2352x1568px:
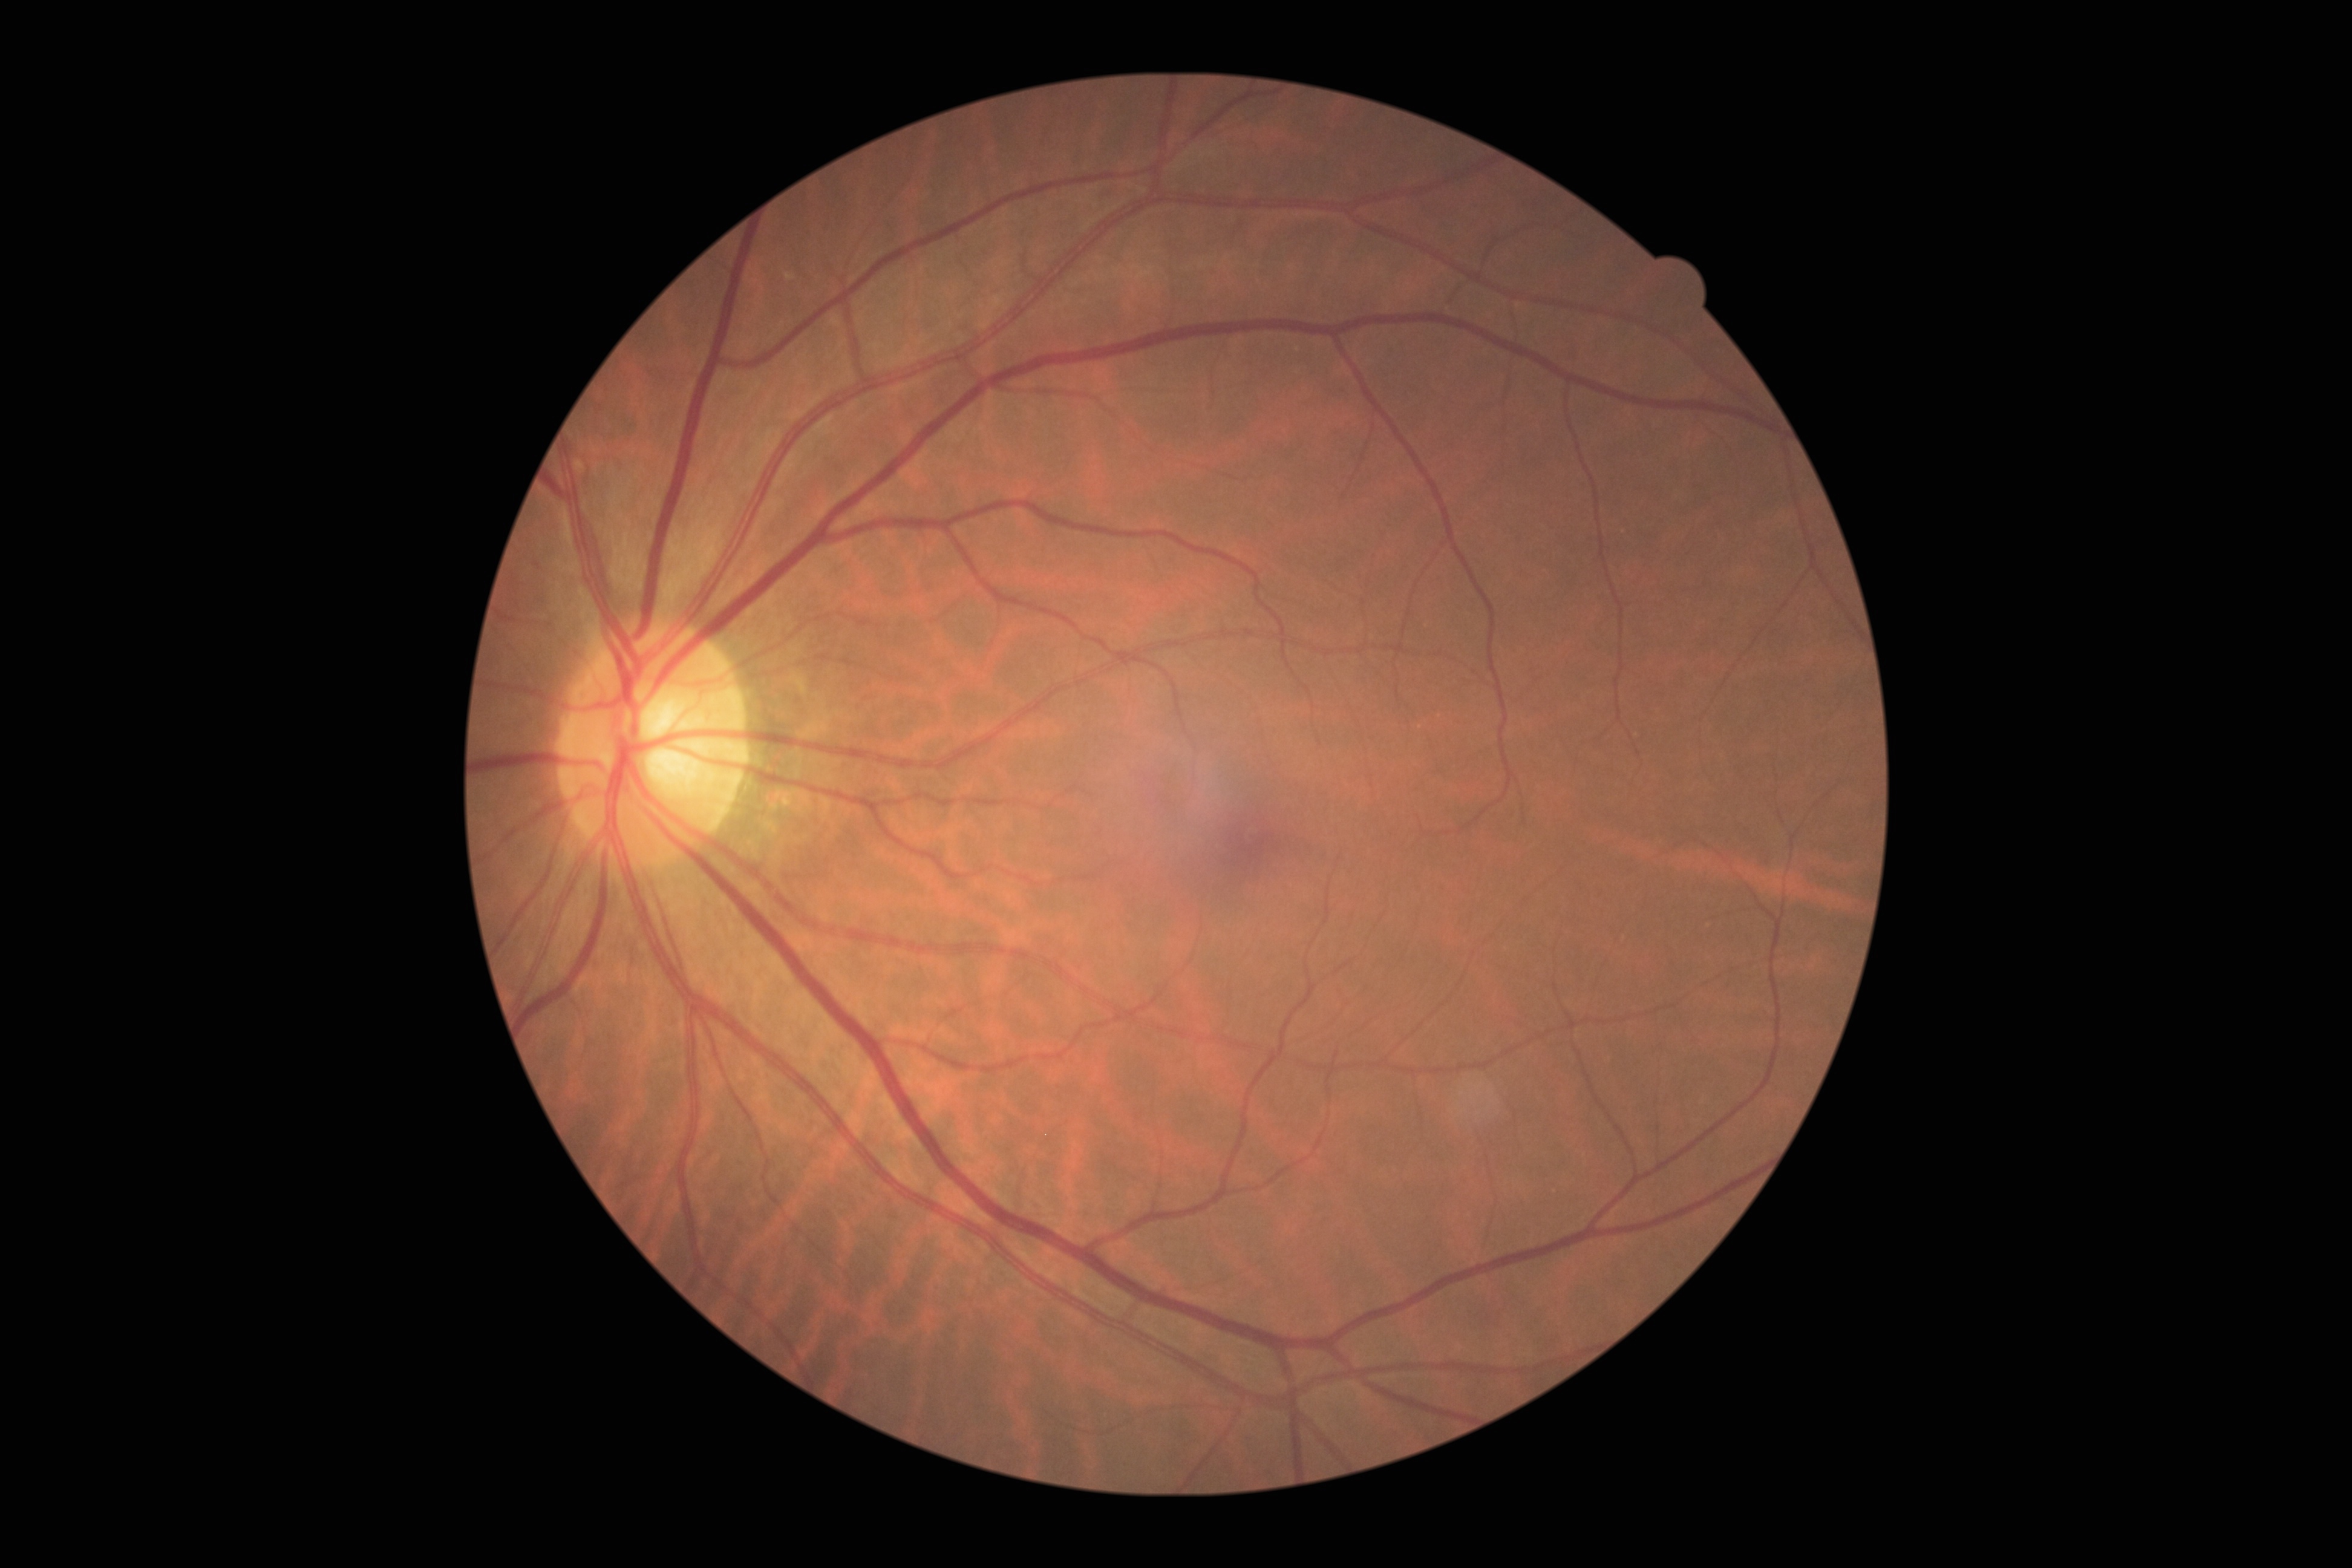

DR severity: 0/4.